848 by 848 pixels — 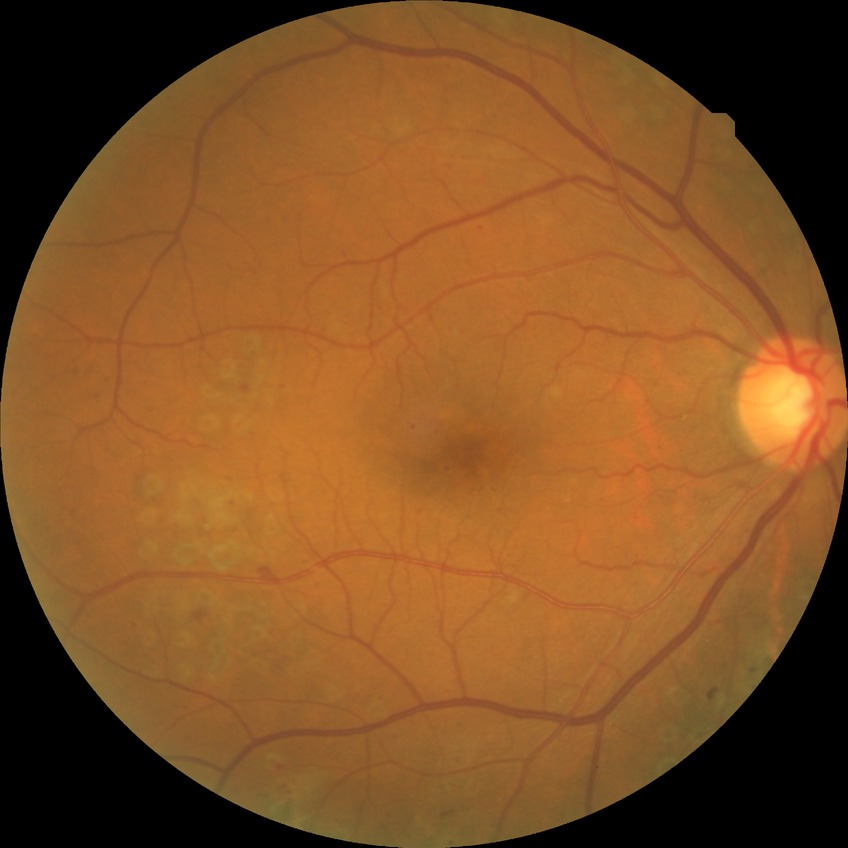
Diabetic retinopathy (DR) is PDR (proliferative diabetic retinopathy).